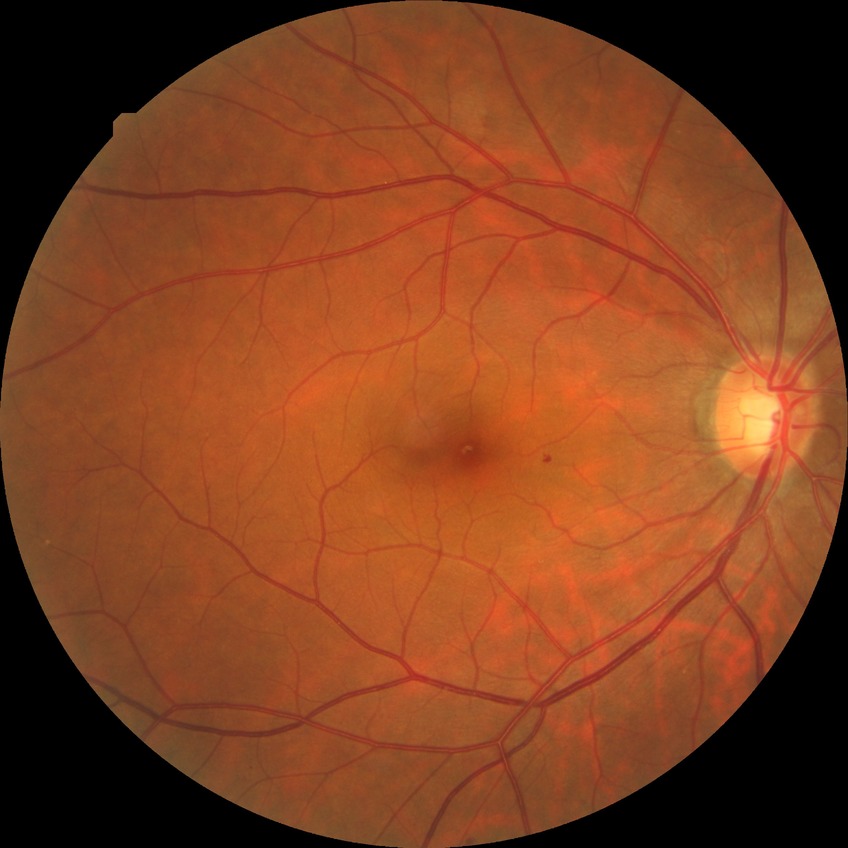
proliferative_class: non-proliferative diabetic retinopathy
davis_grade: simple diabetic retinopathy